Retinal fundus photograph — 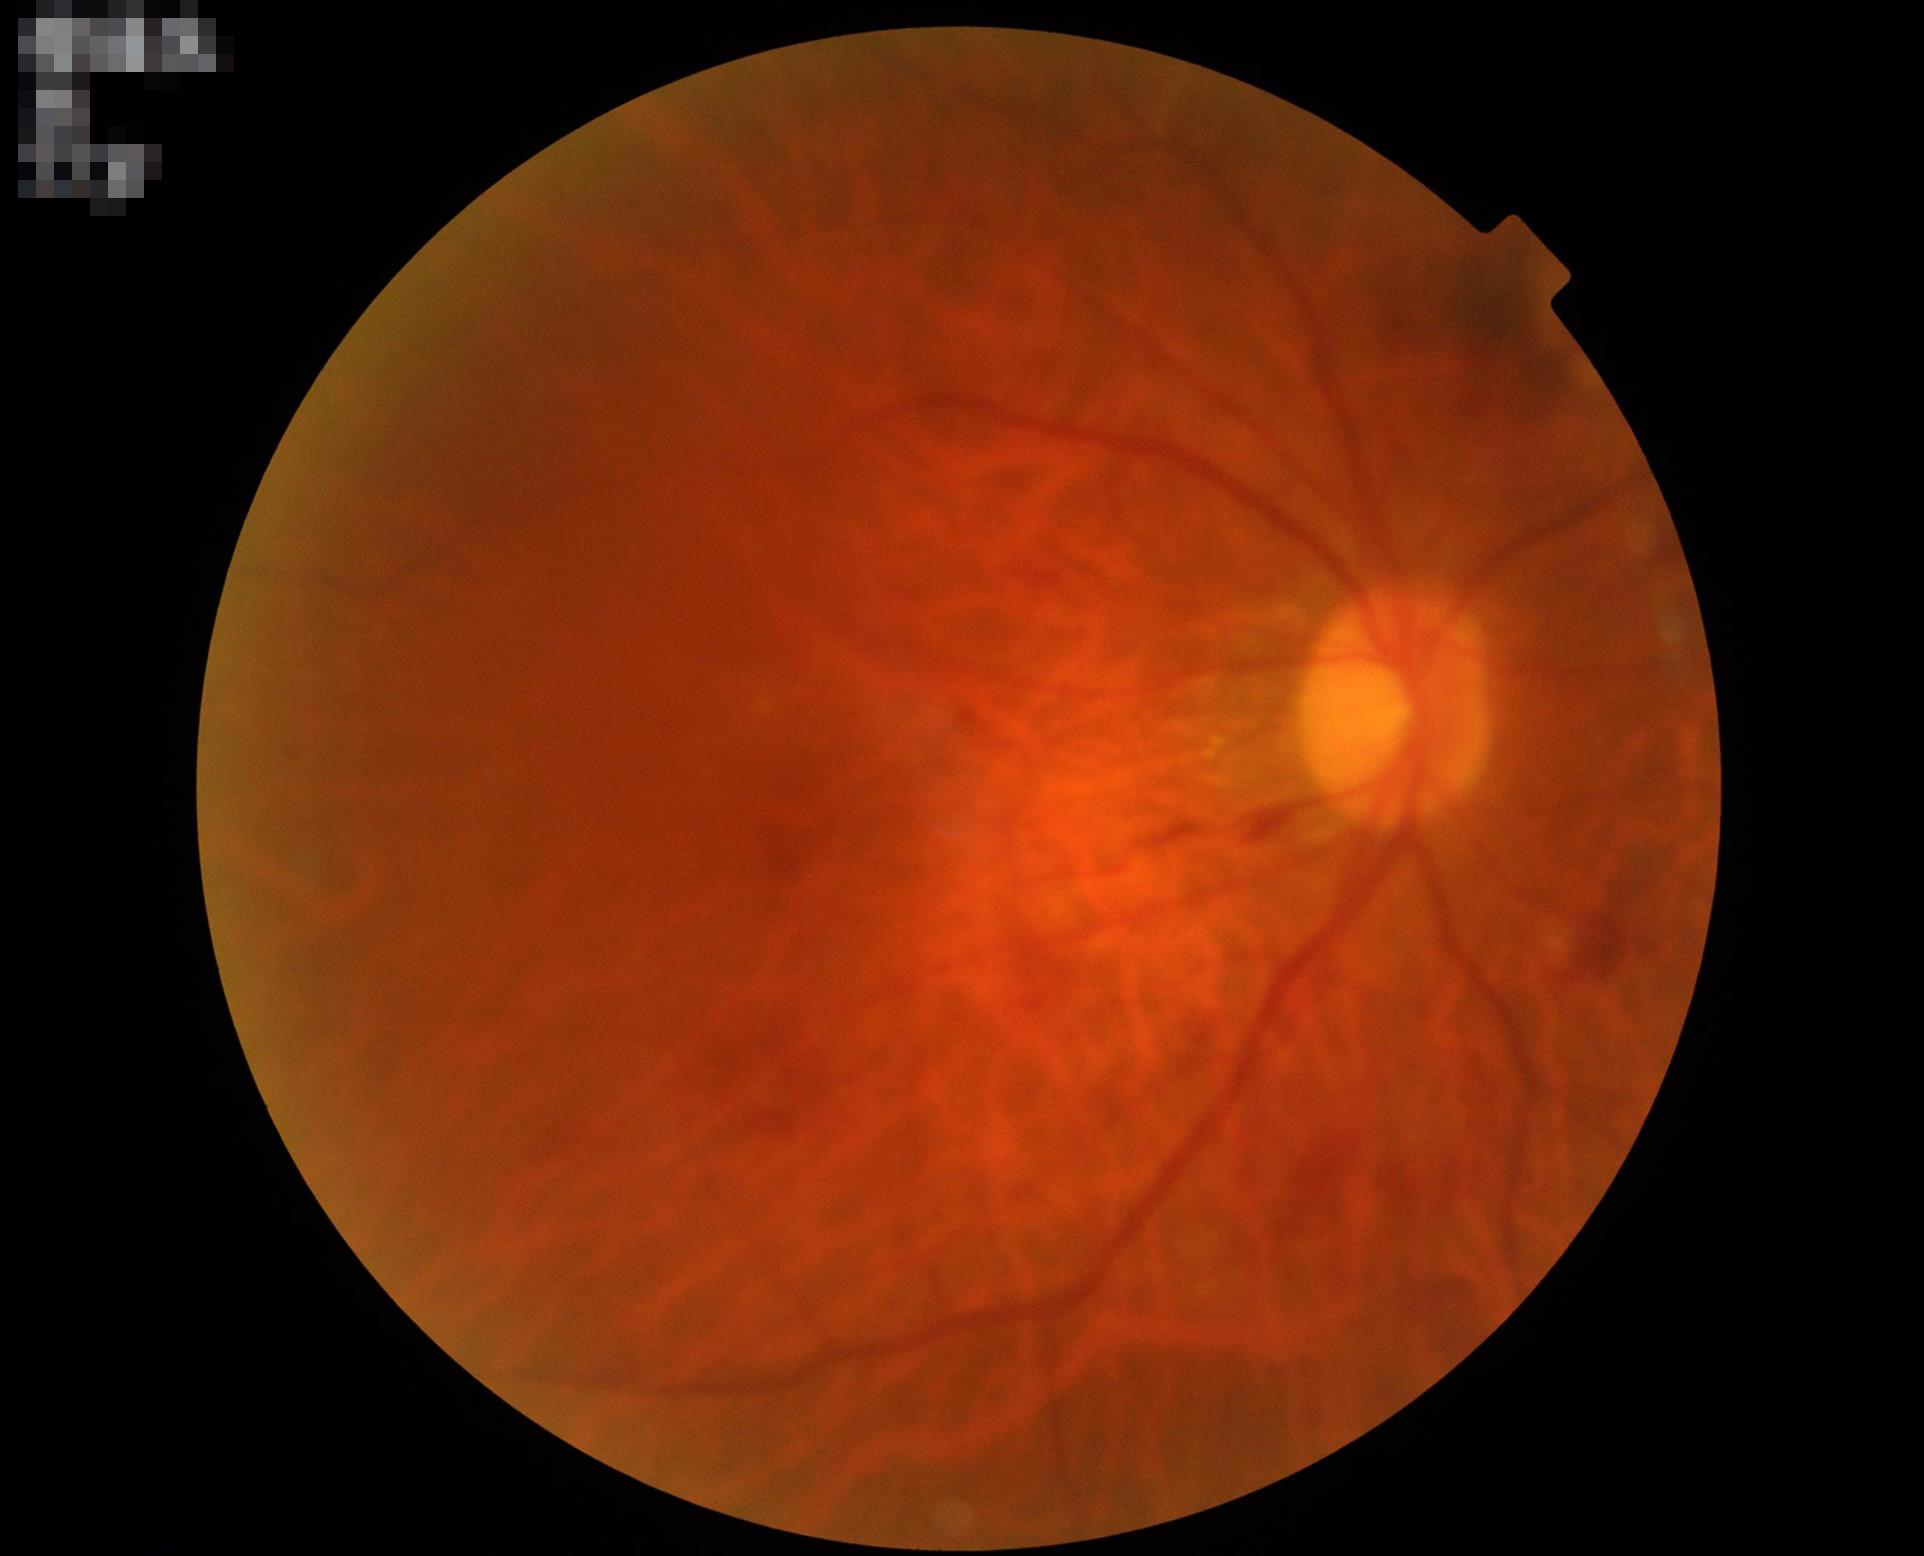

Noticeable blur in the optic disc, vessels, or background. Overall quality is poor; the image is difficult to grade. Illumination and color balance are good.